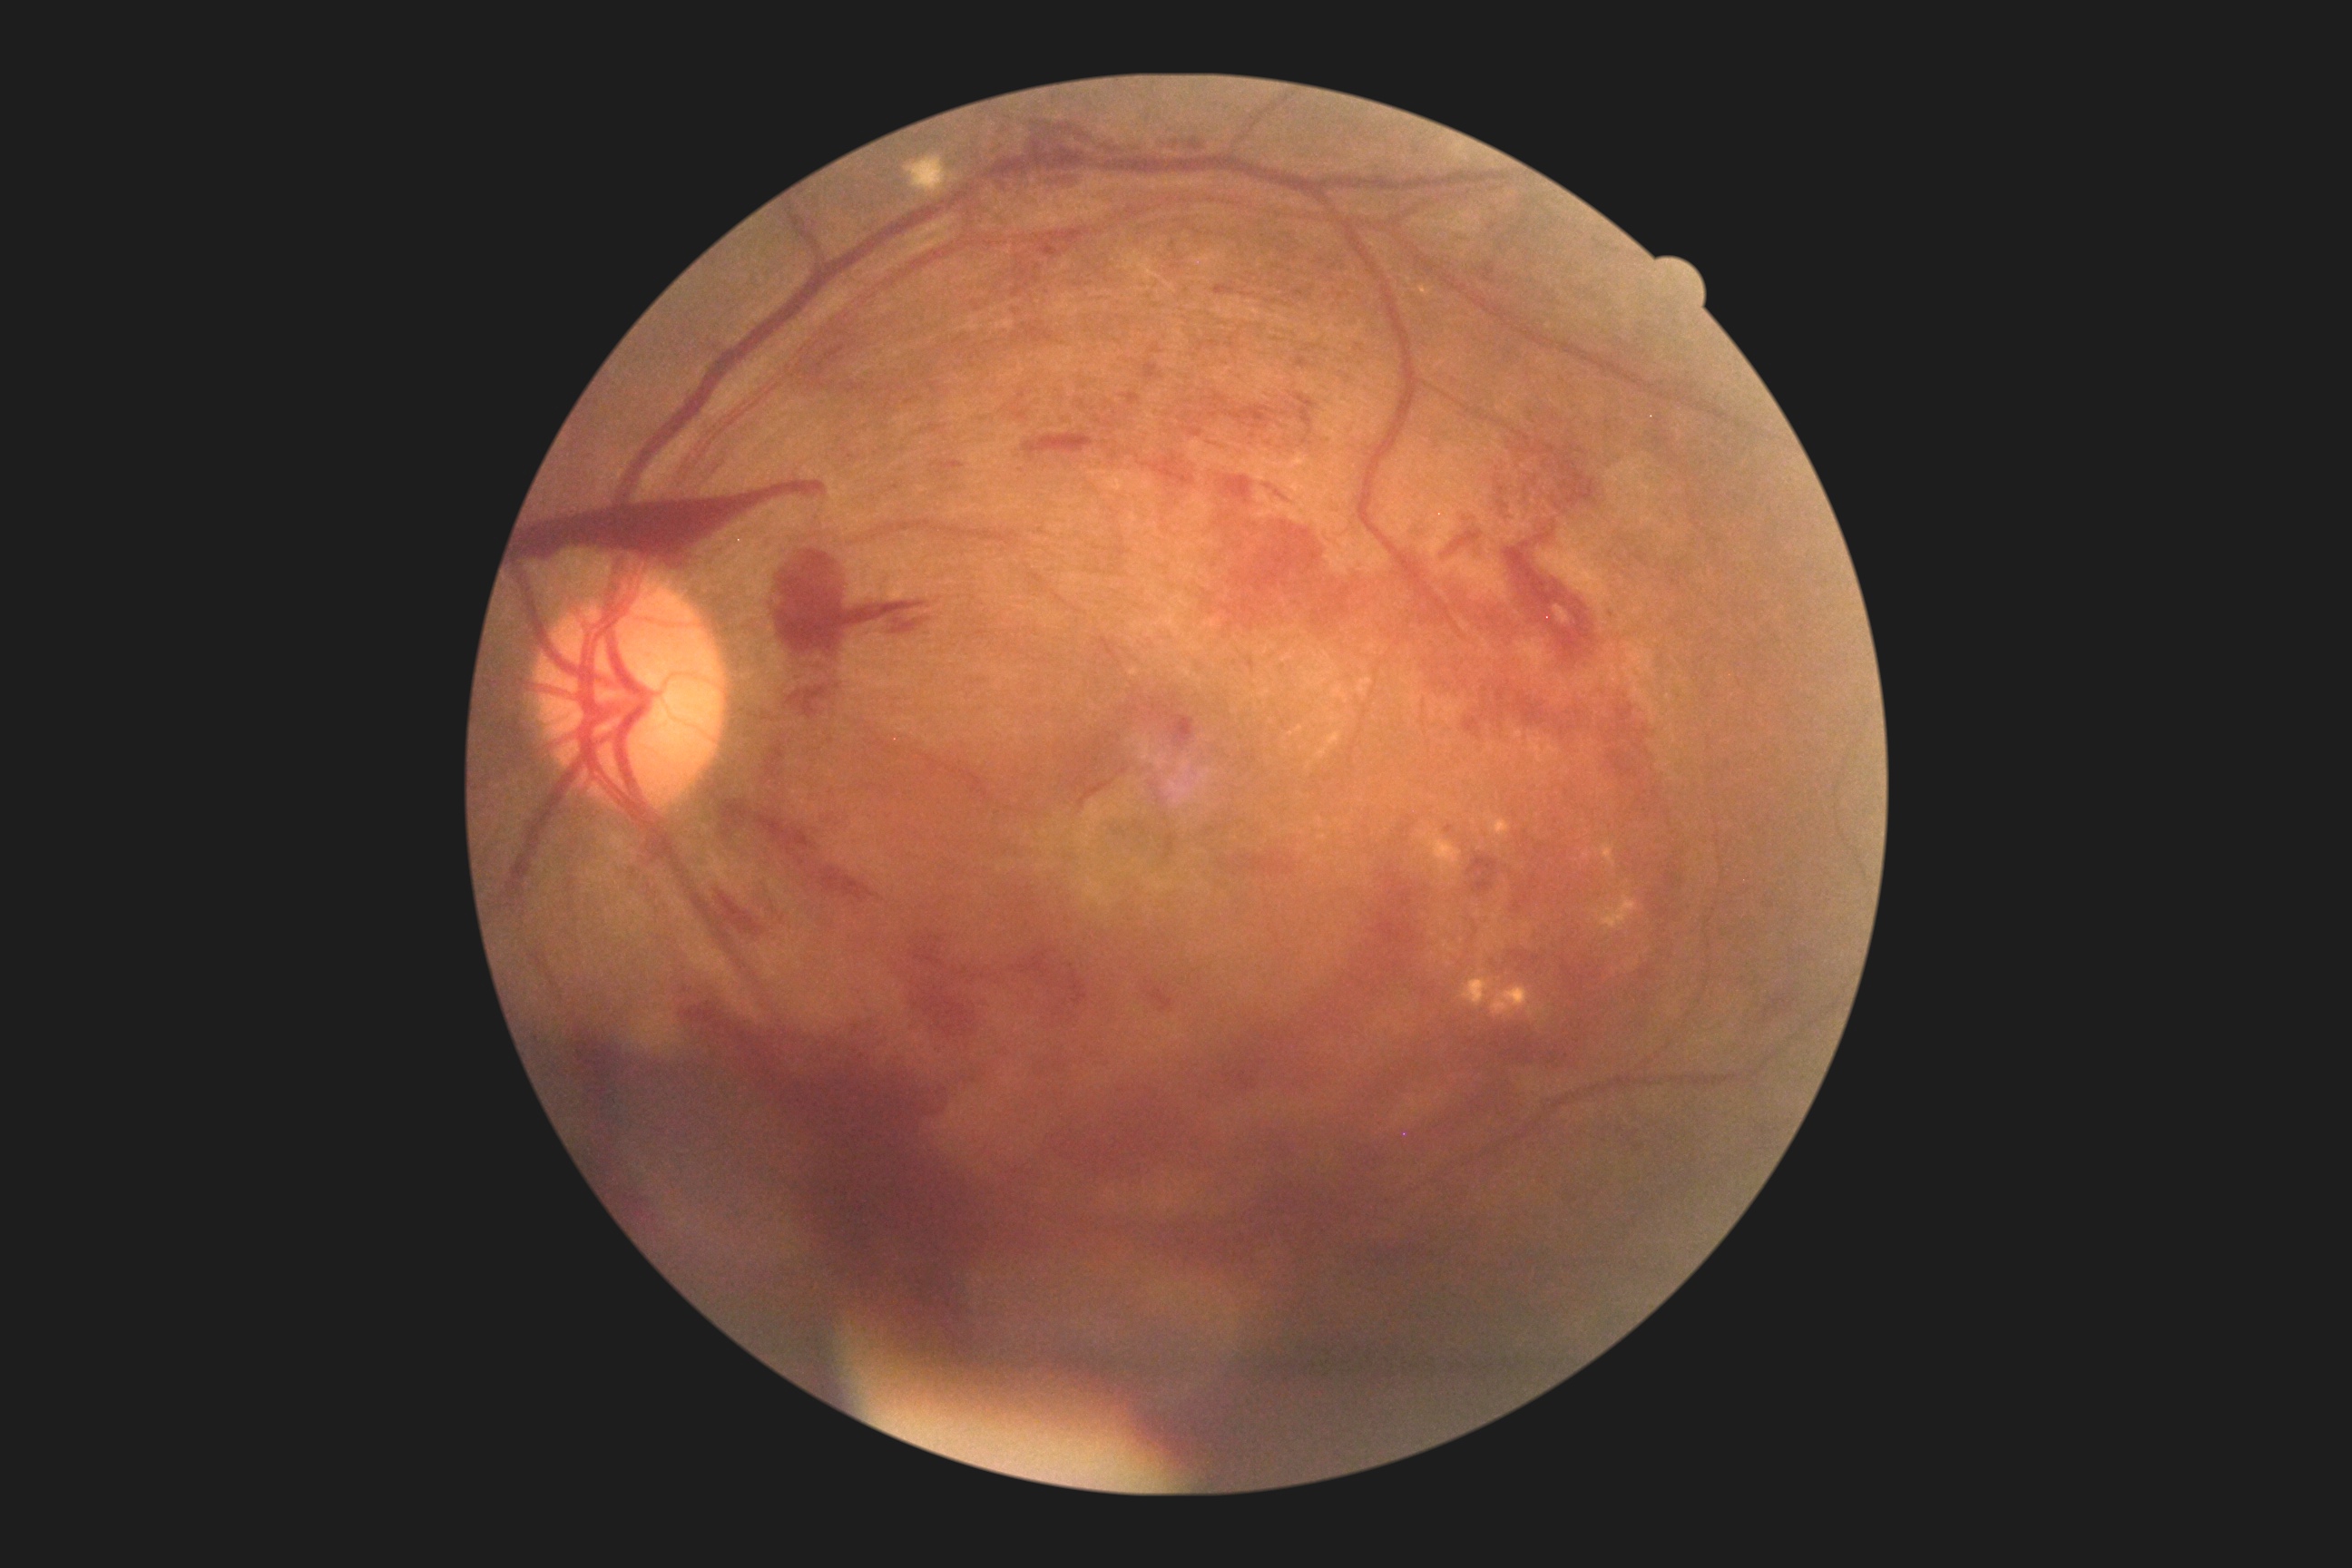 Diabetic retinopathy (DR) is 4/4 — neovascularization and/or vitreous/pre-retinal hemorrhage. DR class: proliferative diabetic retinopathy.